2352x1568 · CFP: 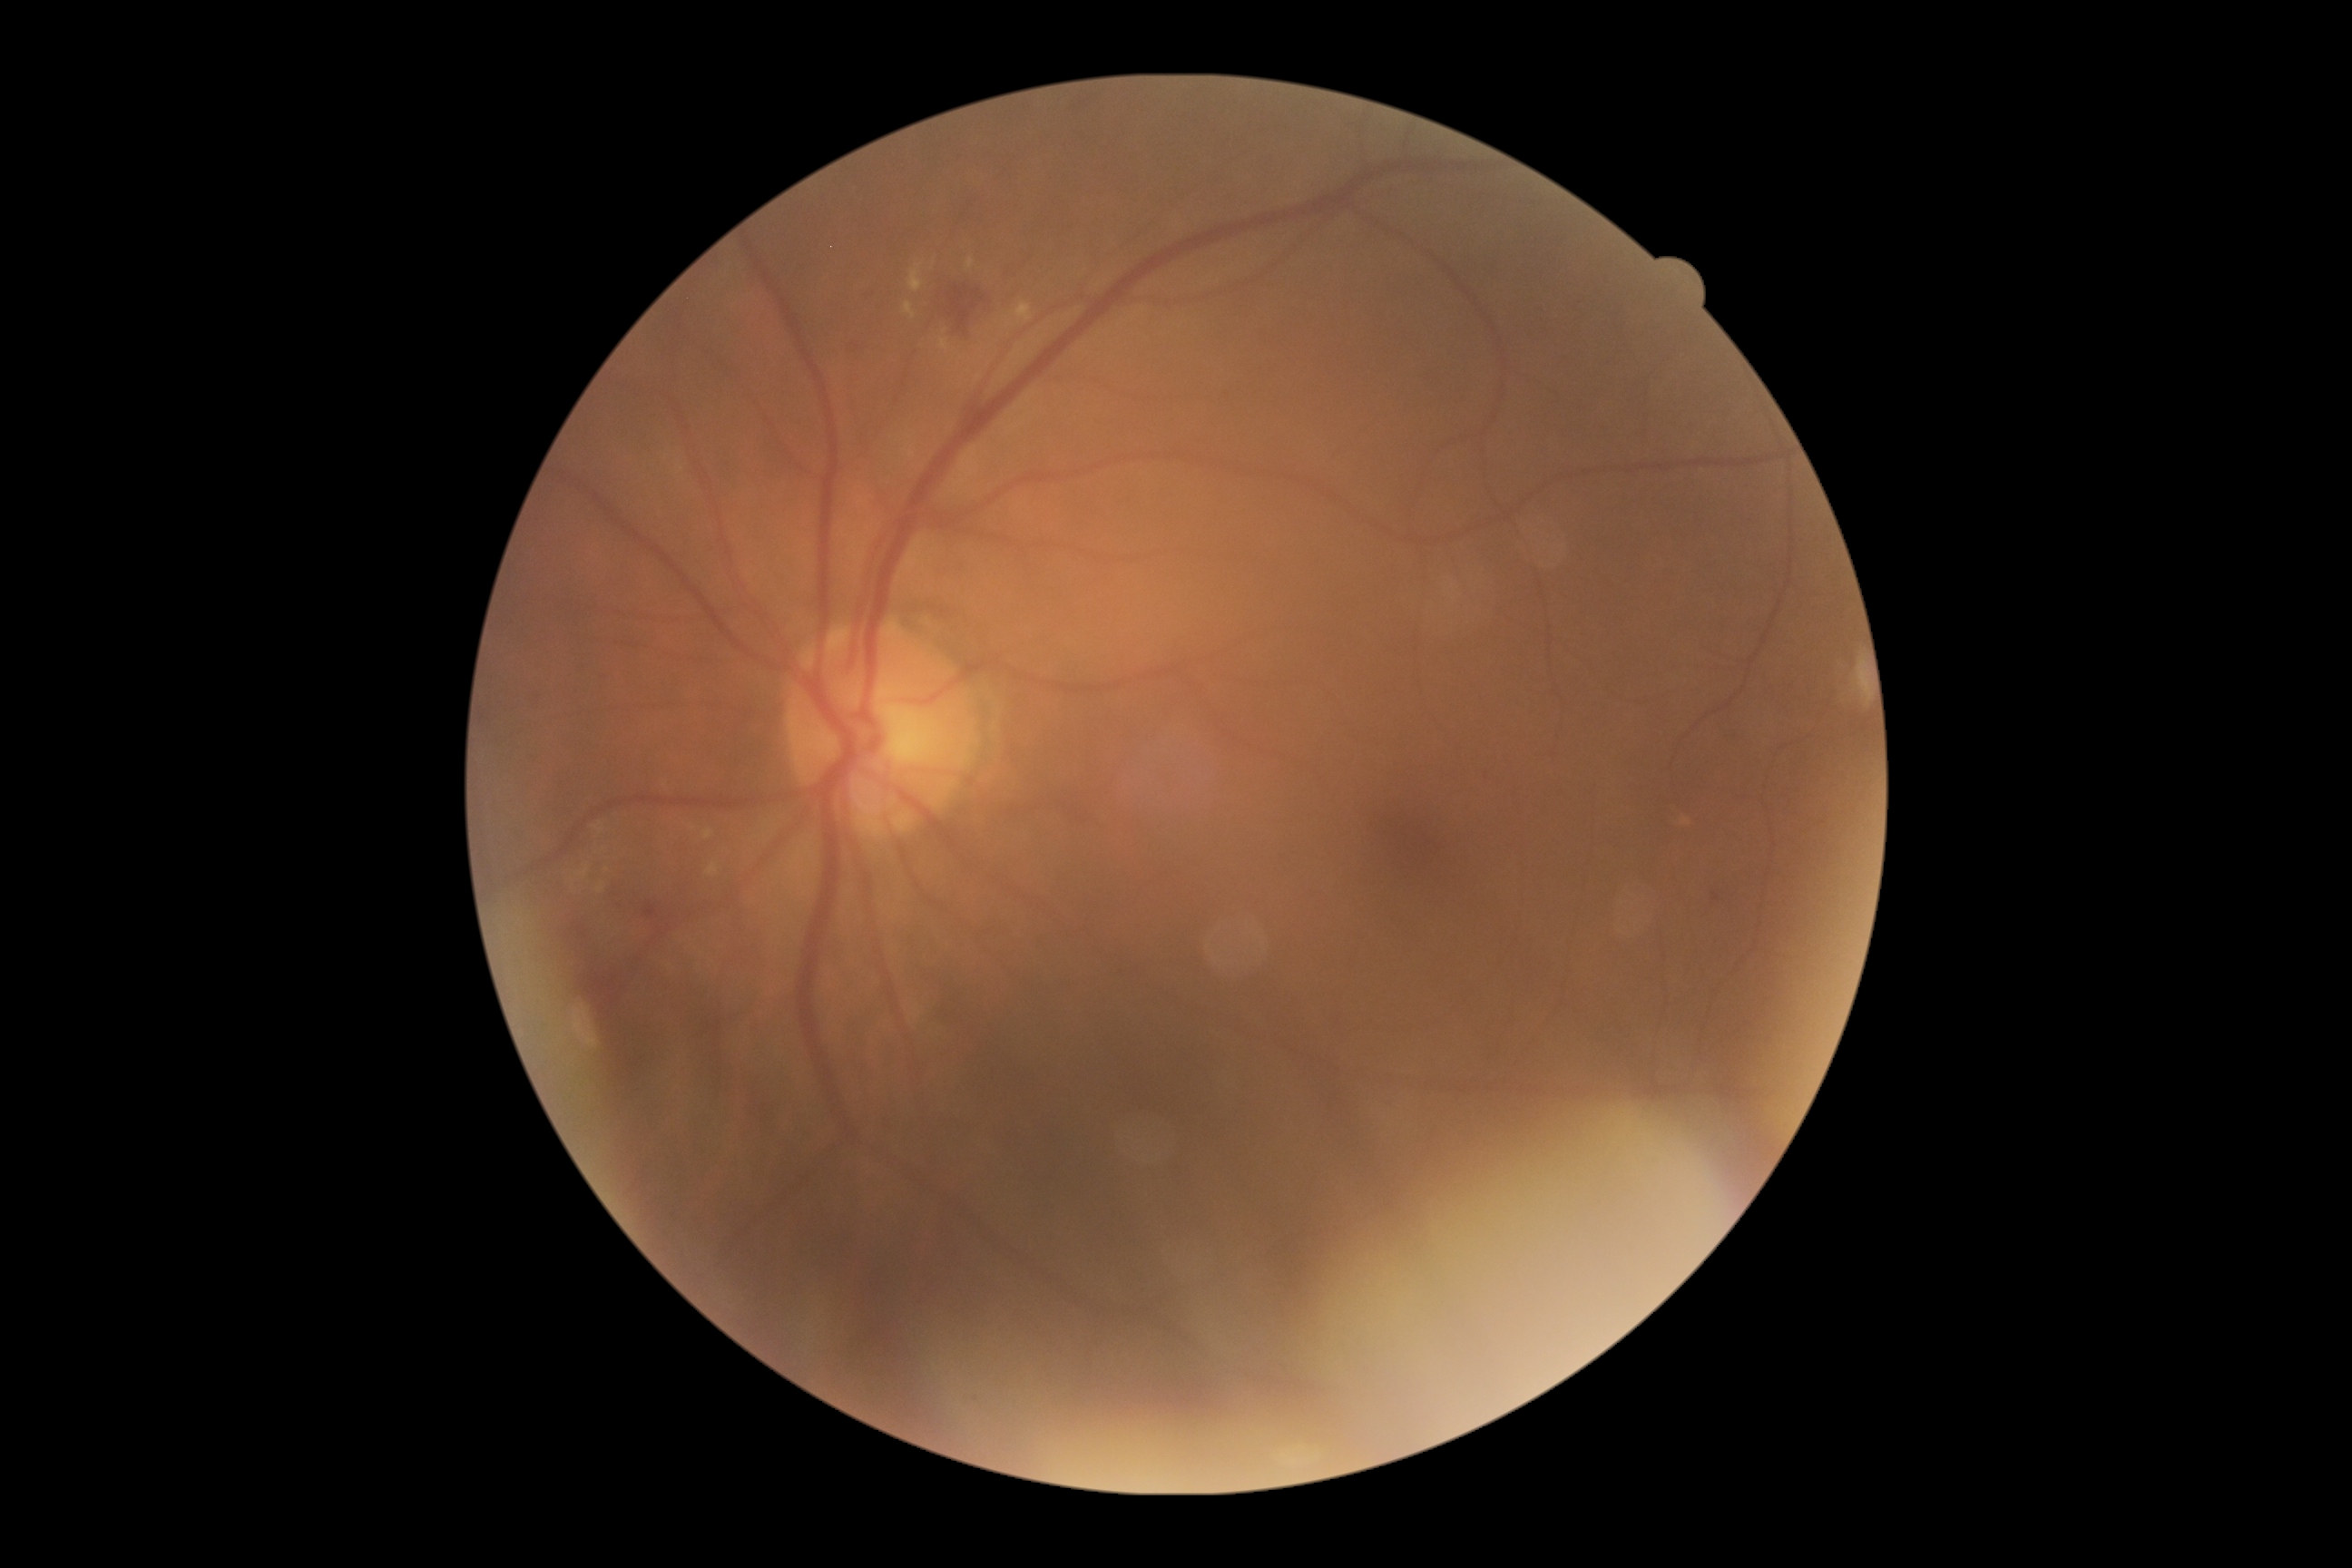 {
  "dr_grade": "moderate NPDR (2)",
  "dr_category": "non-proliferative diabetic retinopathy"
}